Without pupil dilation, fundus photo, NIDEK AFC-230, 45° field of view — 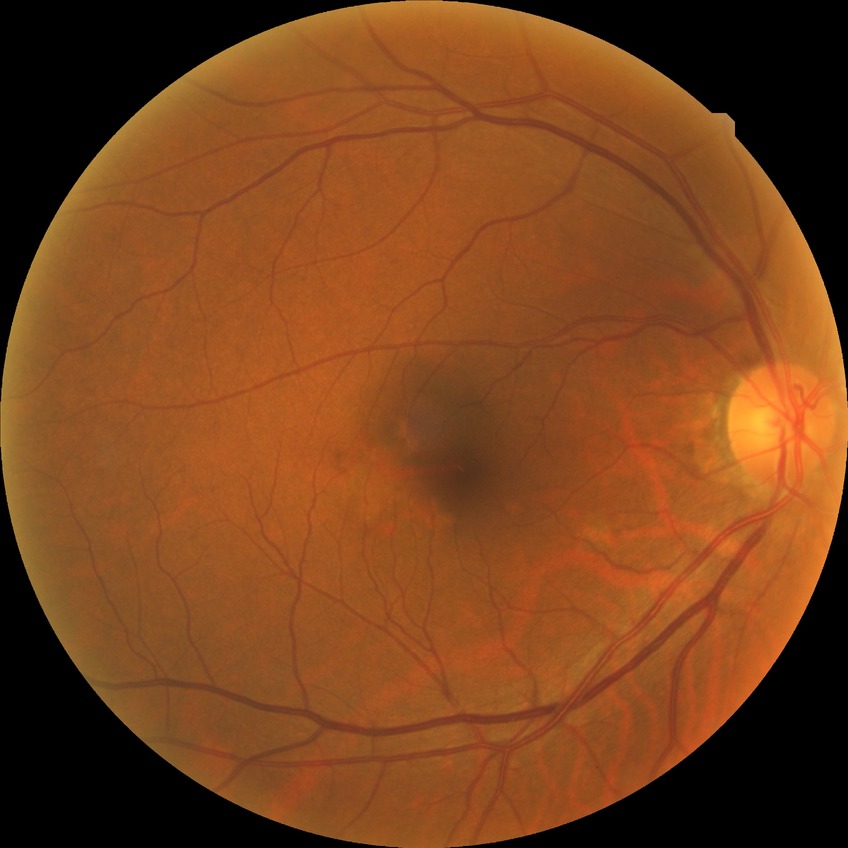 Diabetic retinopathy (DR) is NDR (no diabetic retinopathy).